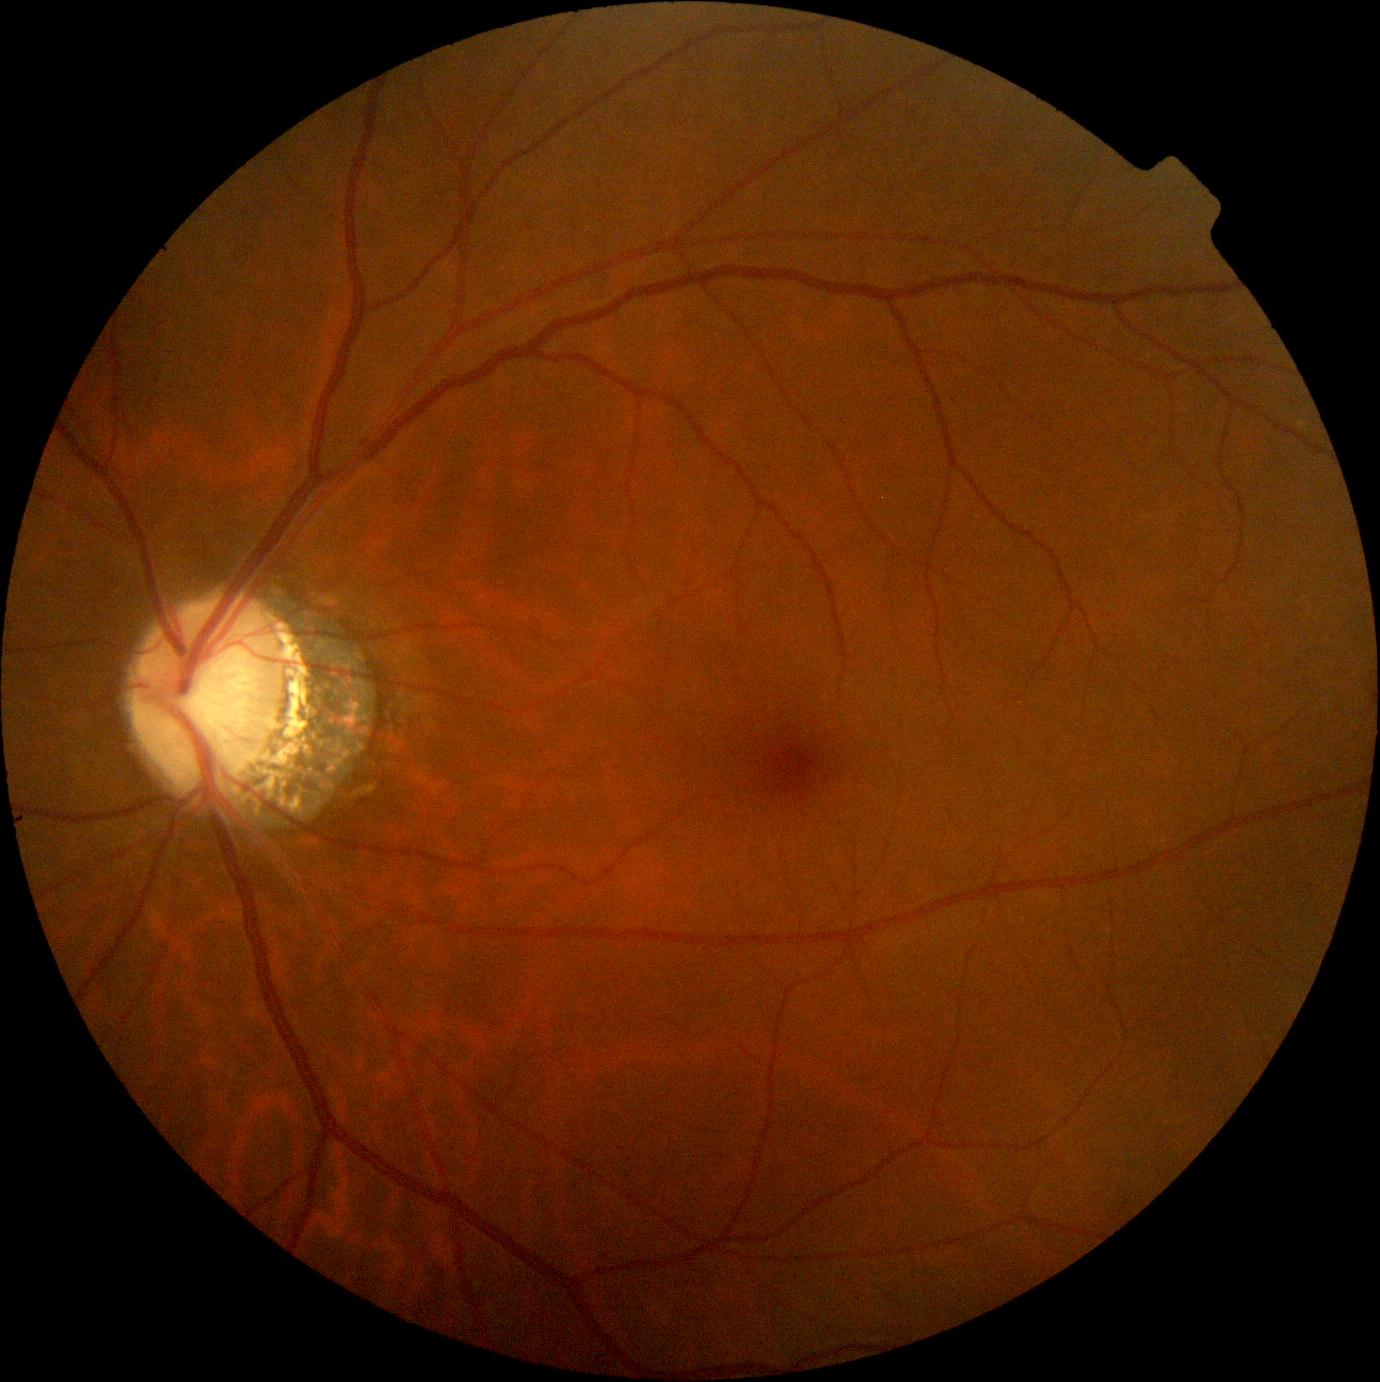

Diabetic retinopathy grade is 0/4 — no visible signs of diabetic retinopathy.